Wide-field fundus photograph of an infant.
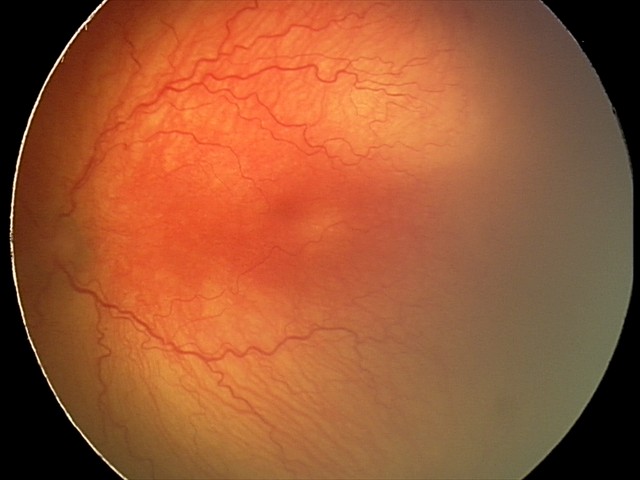

Diagnosis from this screening exam: A-ROP (aggressive ROP).